Wide-field fundus image from infant ROP screening:
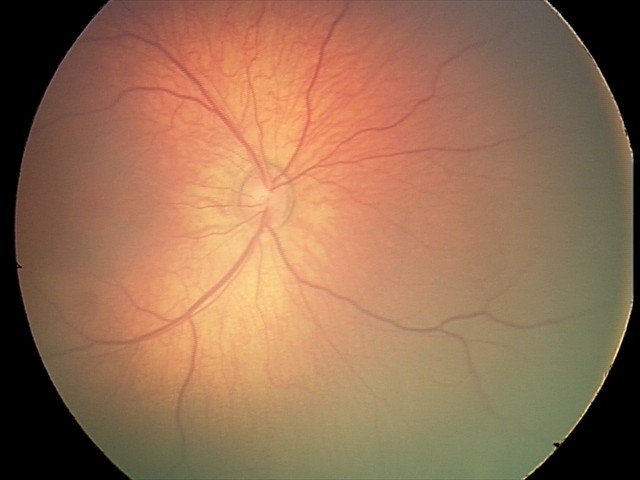
Screening examination diagnosed as physiological.